Camera: Nidek AFC-330. Captured without pupil dilation.
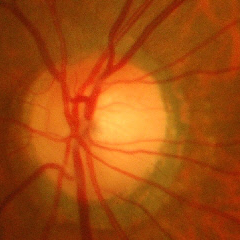

Findings consistent with glaucoma.
Advanced glaucoma.